Infant wide-field retinal image · 640x480 — 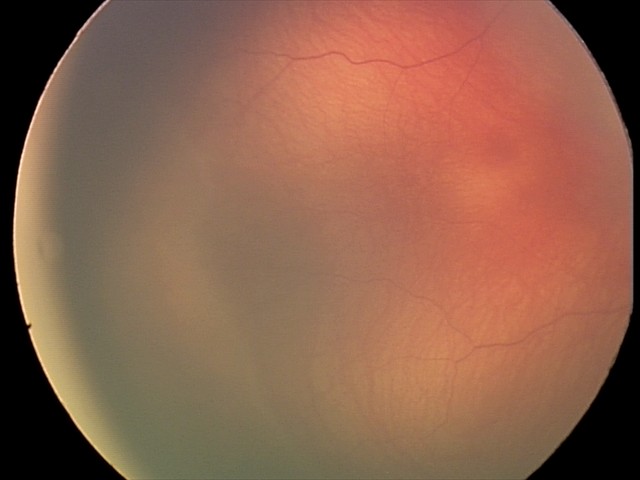 Diagnosis from this screening exam: retinopathy of prematurity (ROP) stage 2. Without plus disease.